DR severity per modified Davis staging; without pupil dilation; CFP:
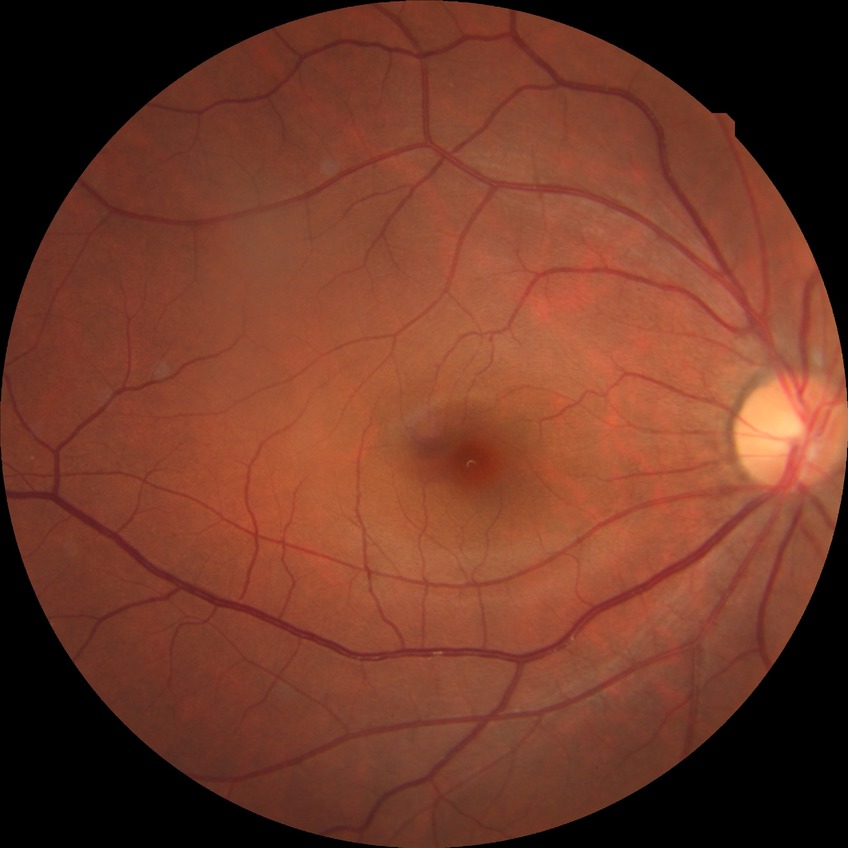 Diabetic retinopathy (DR) is no diabetic retinopathy (NDR).